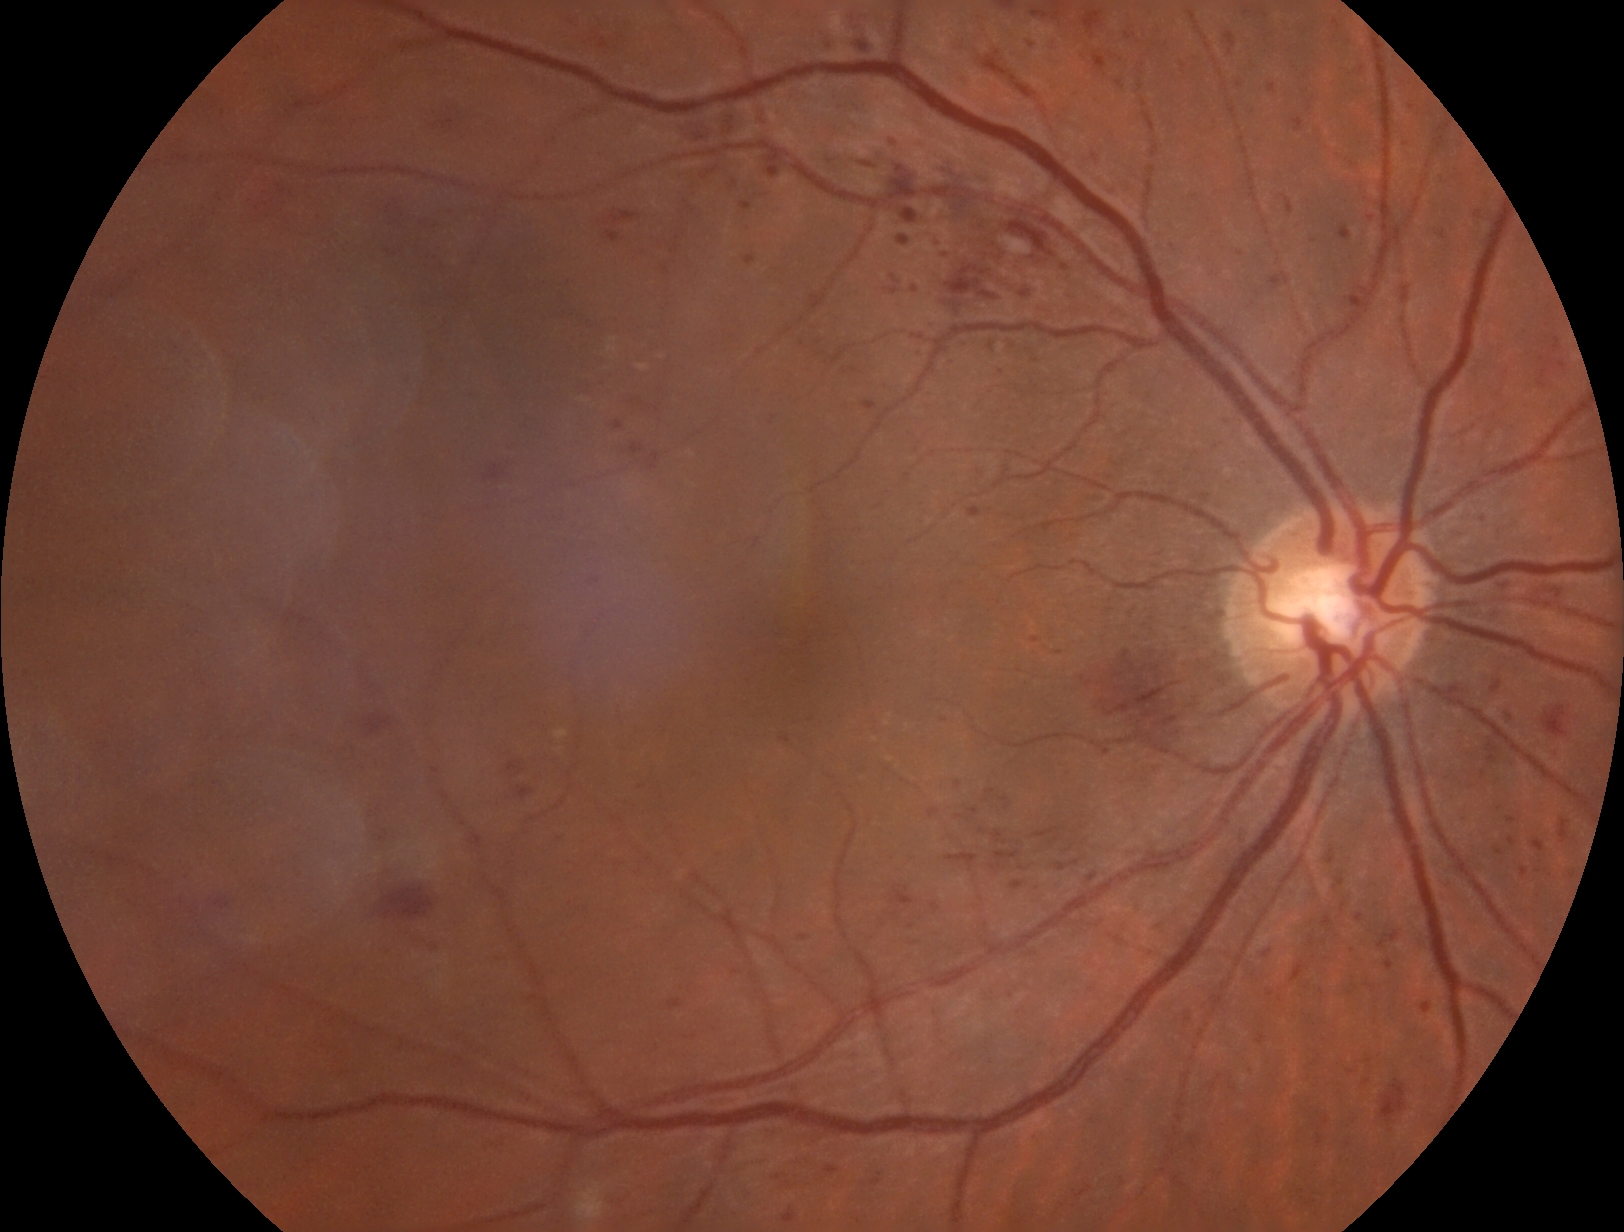

diabetic retinopathy (DR) = severe non-proliferative diabetic retinopathy (grade 3).